1440 by 1080 pixels. Acquired on the Natus RetCam Envision. Pediatric wide-field fundus photograph.
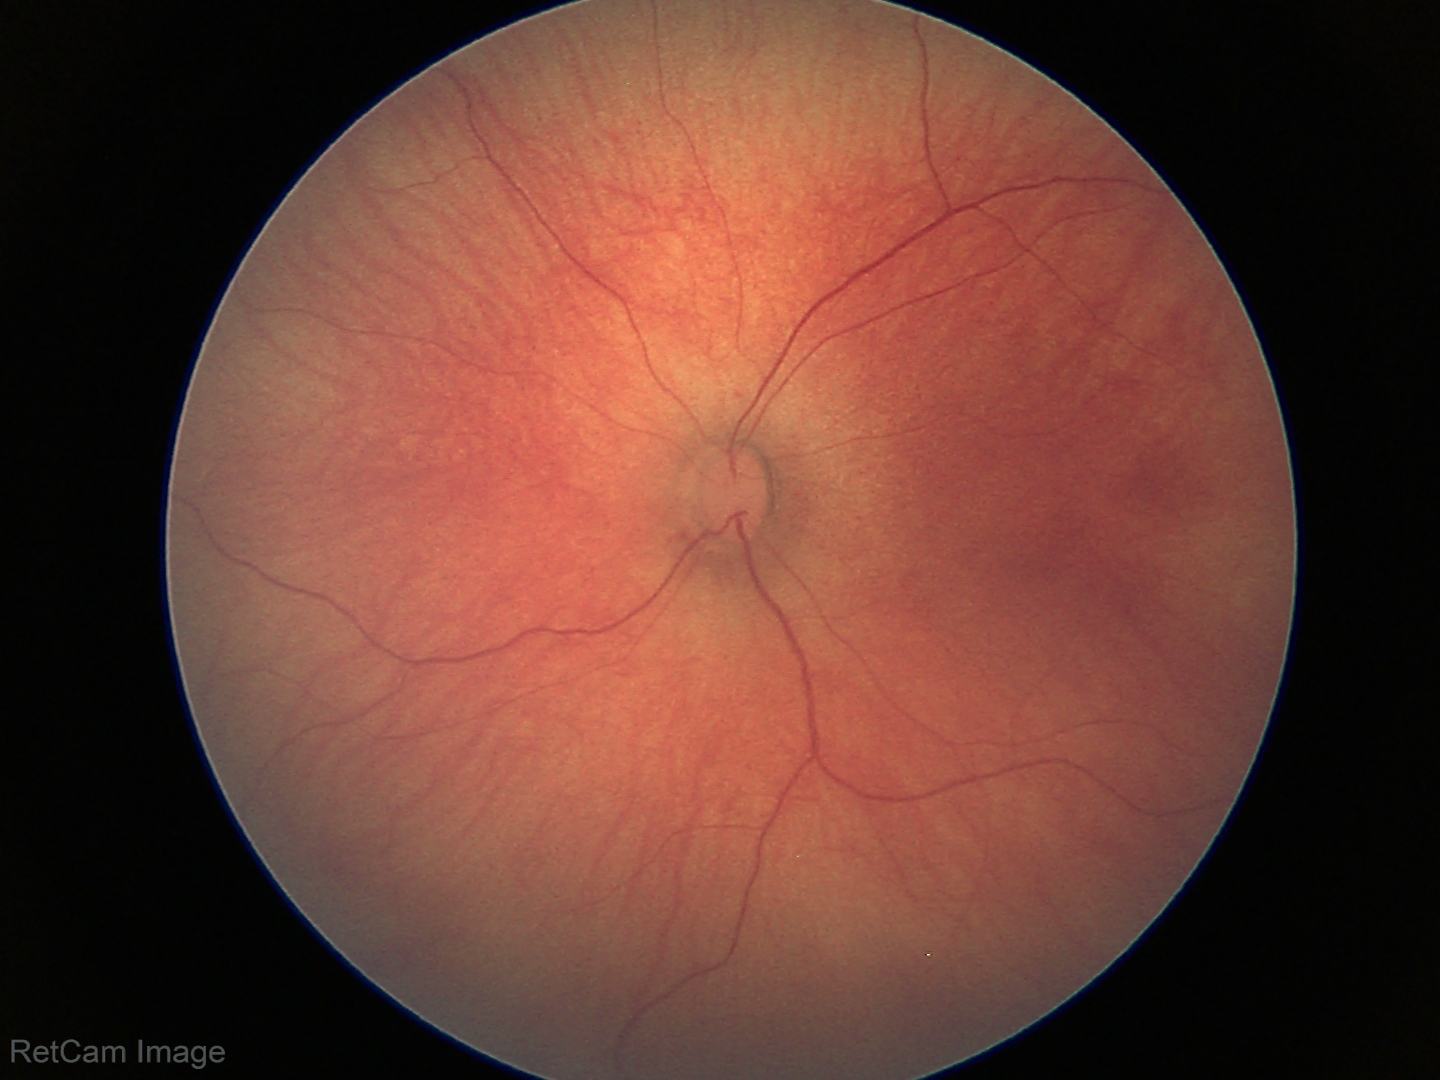
Screening examination with no abnormal retinal findings.